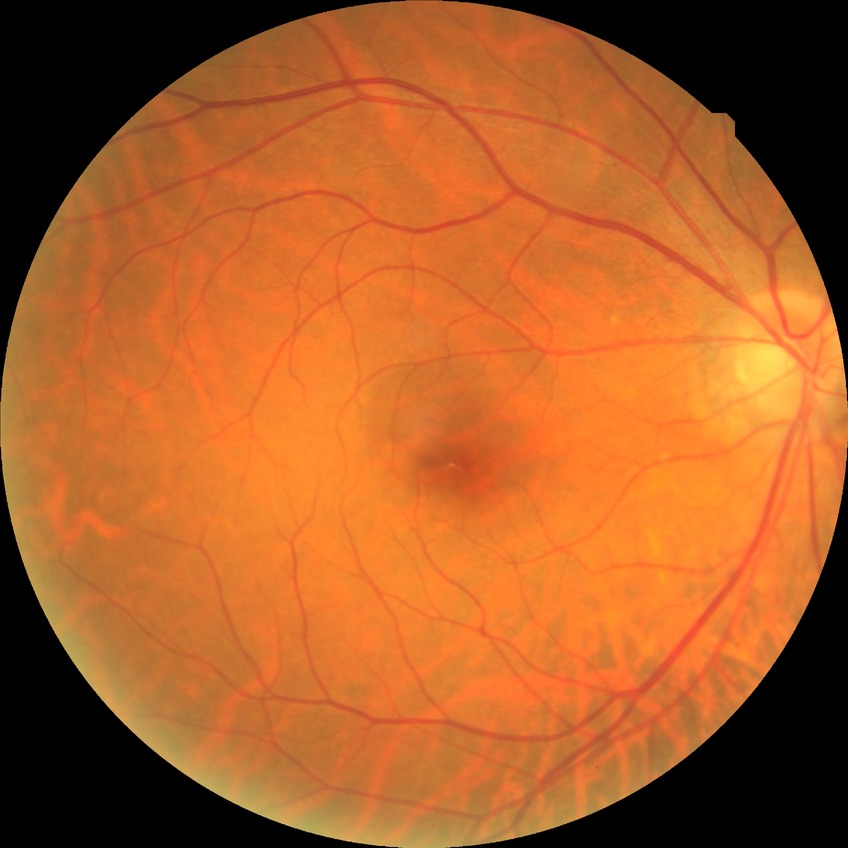 Retinopathy grade is no diabetic retinopathy.